45-degree field of view
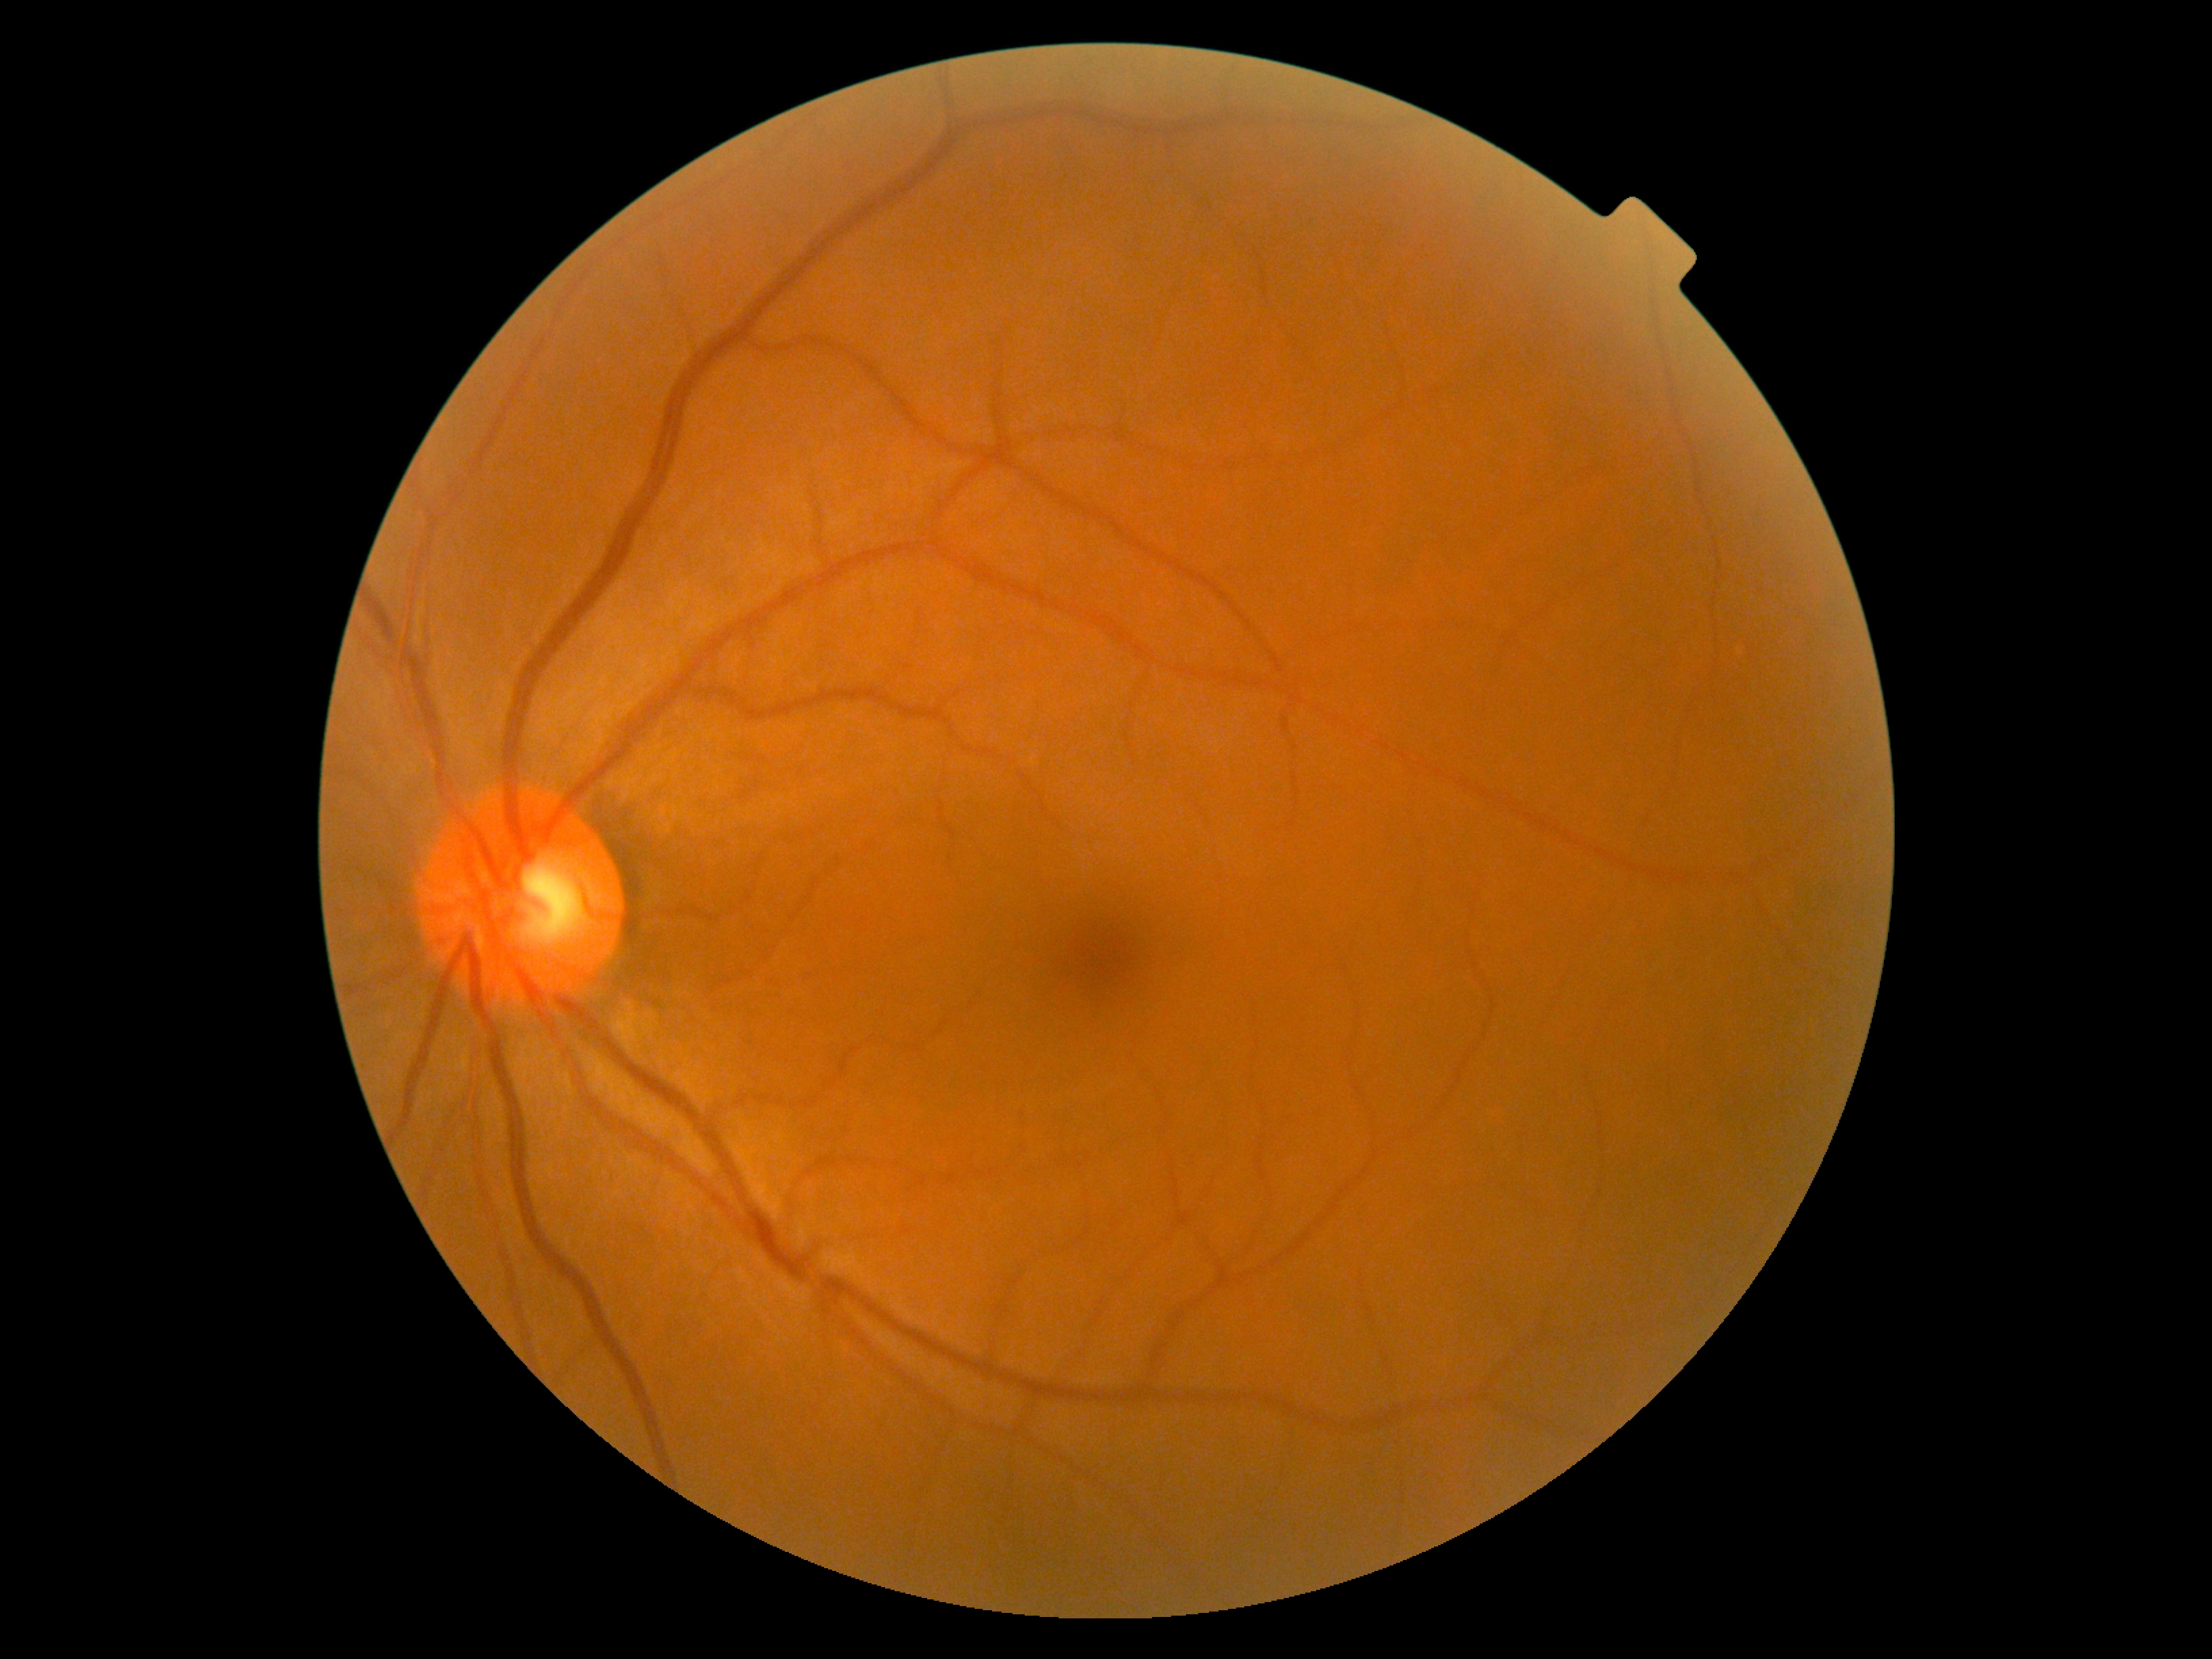
Retinopathy is no apparent diabetic retinopathy (grade 0). No signs of diabetic retinopathy.